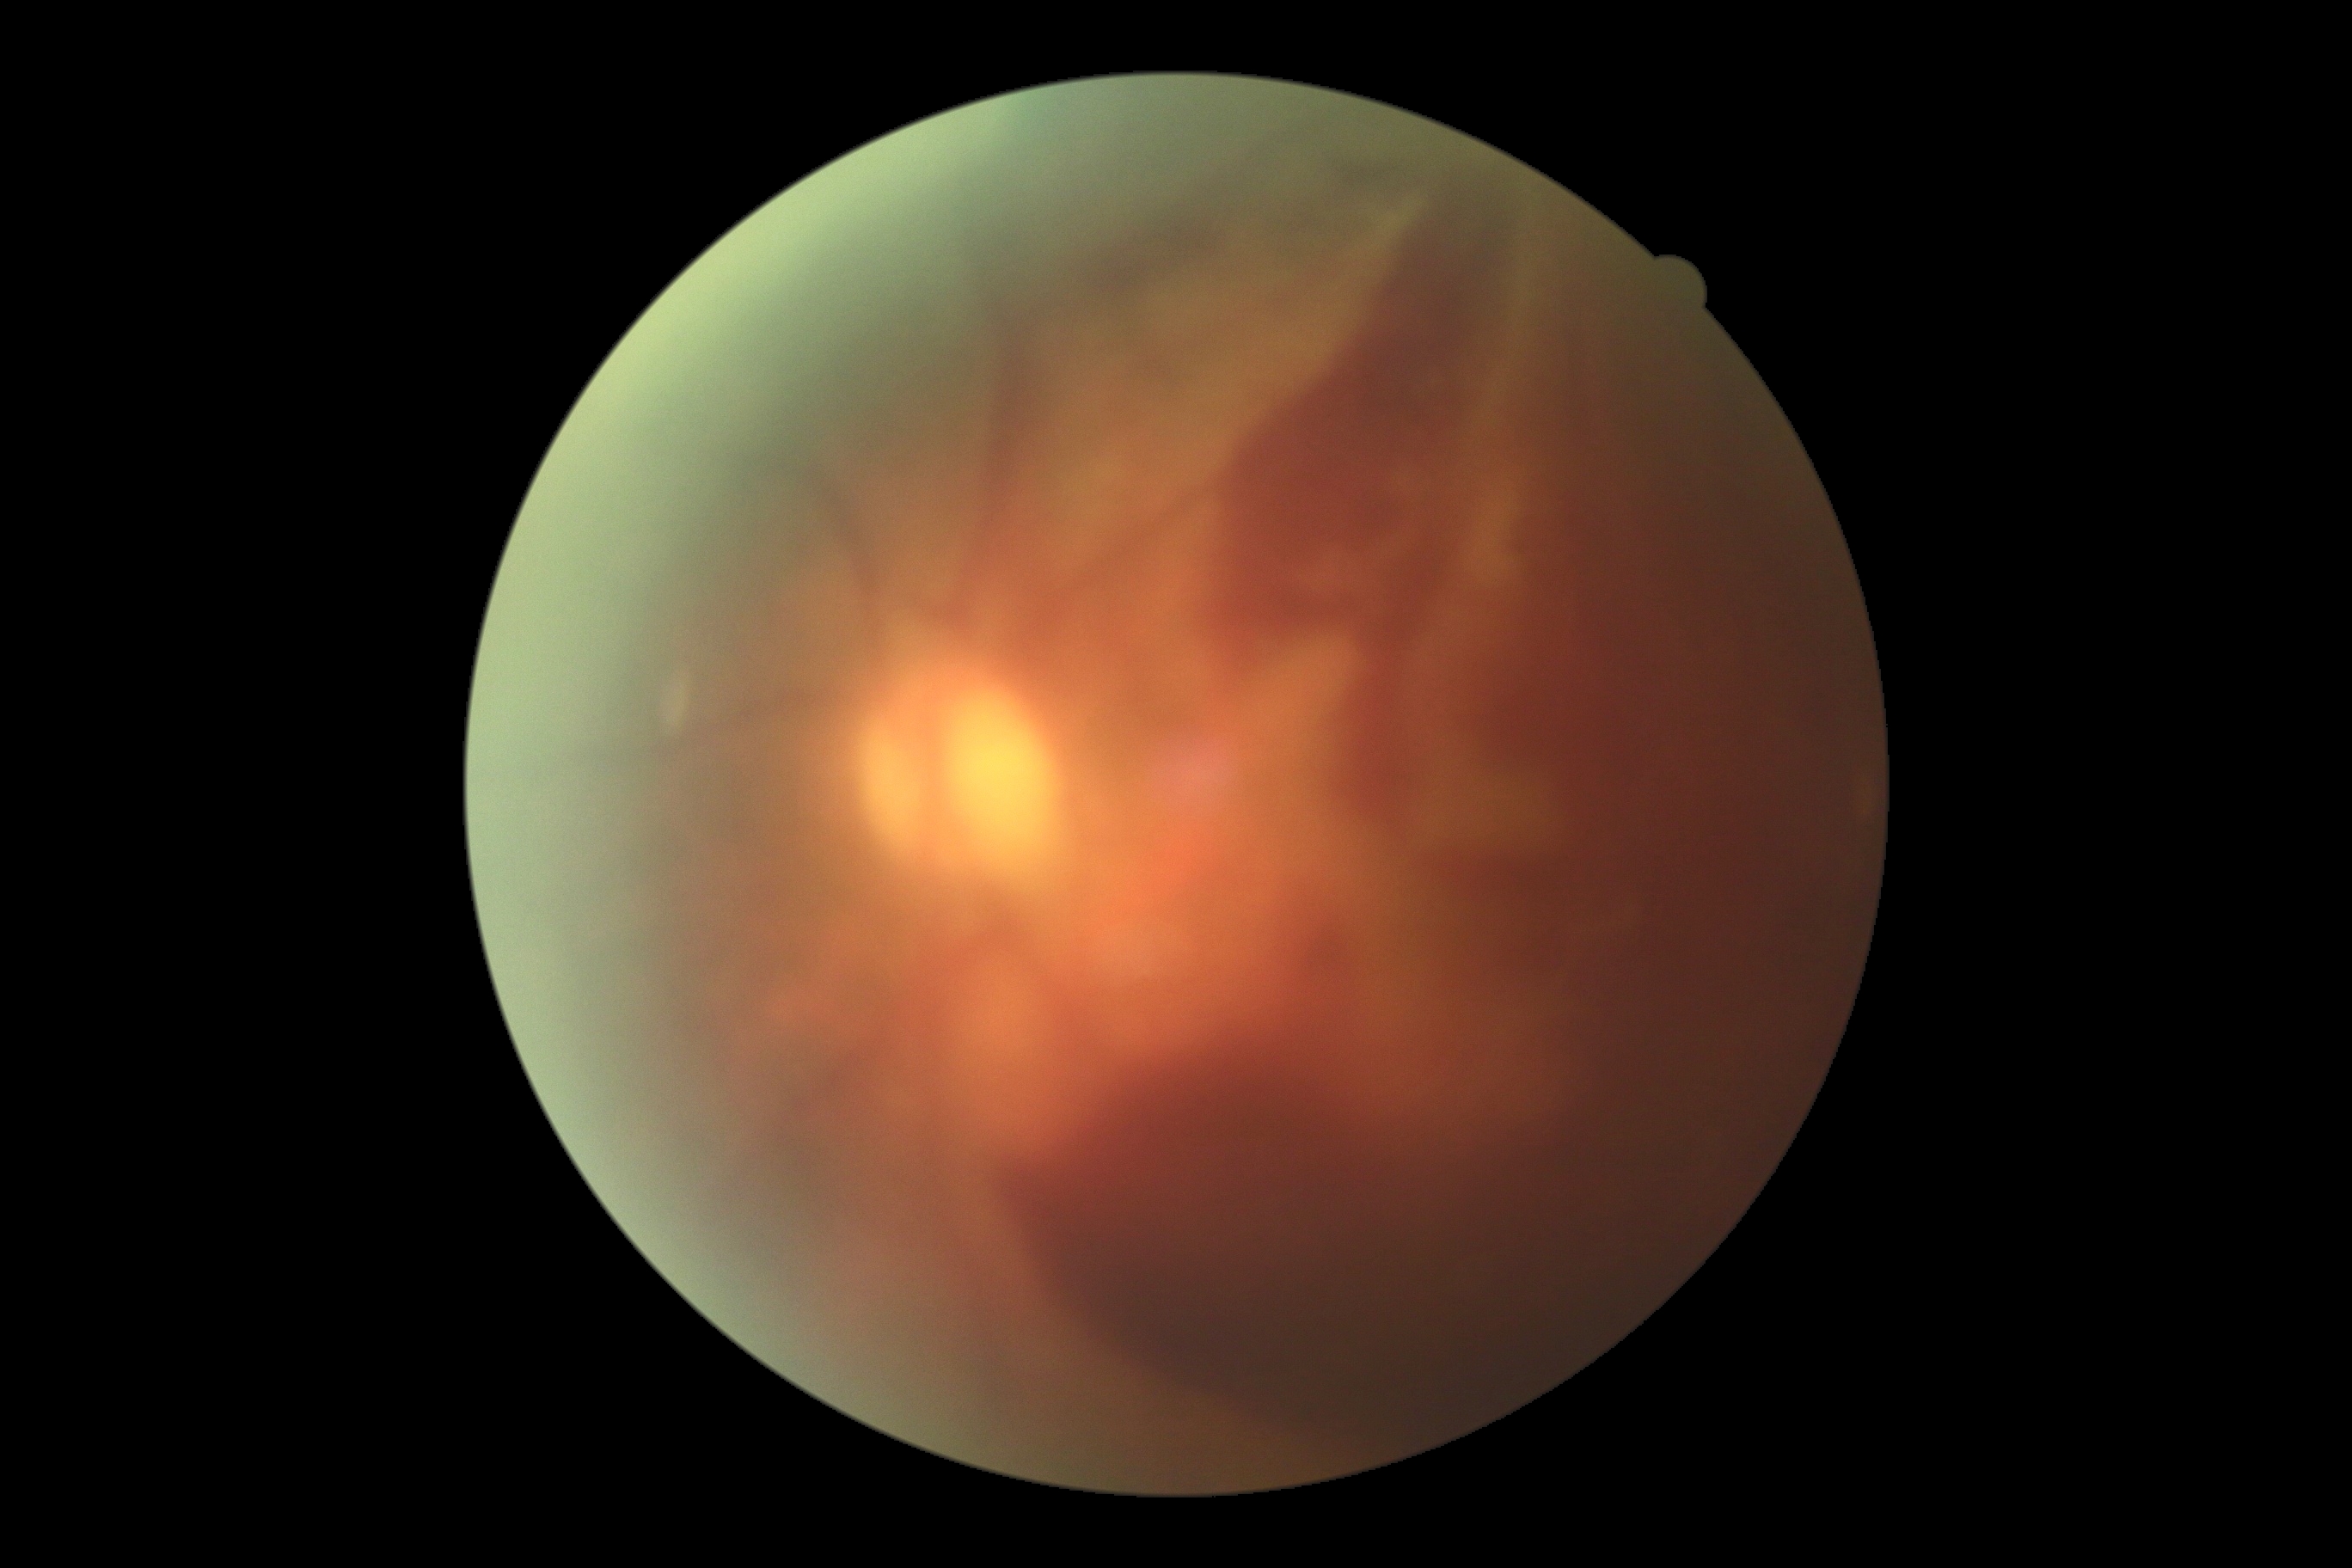 DR: 4 — neovascularization and/or vitreous/pre-retinal hemorrhage.